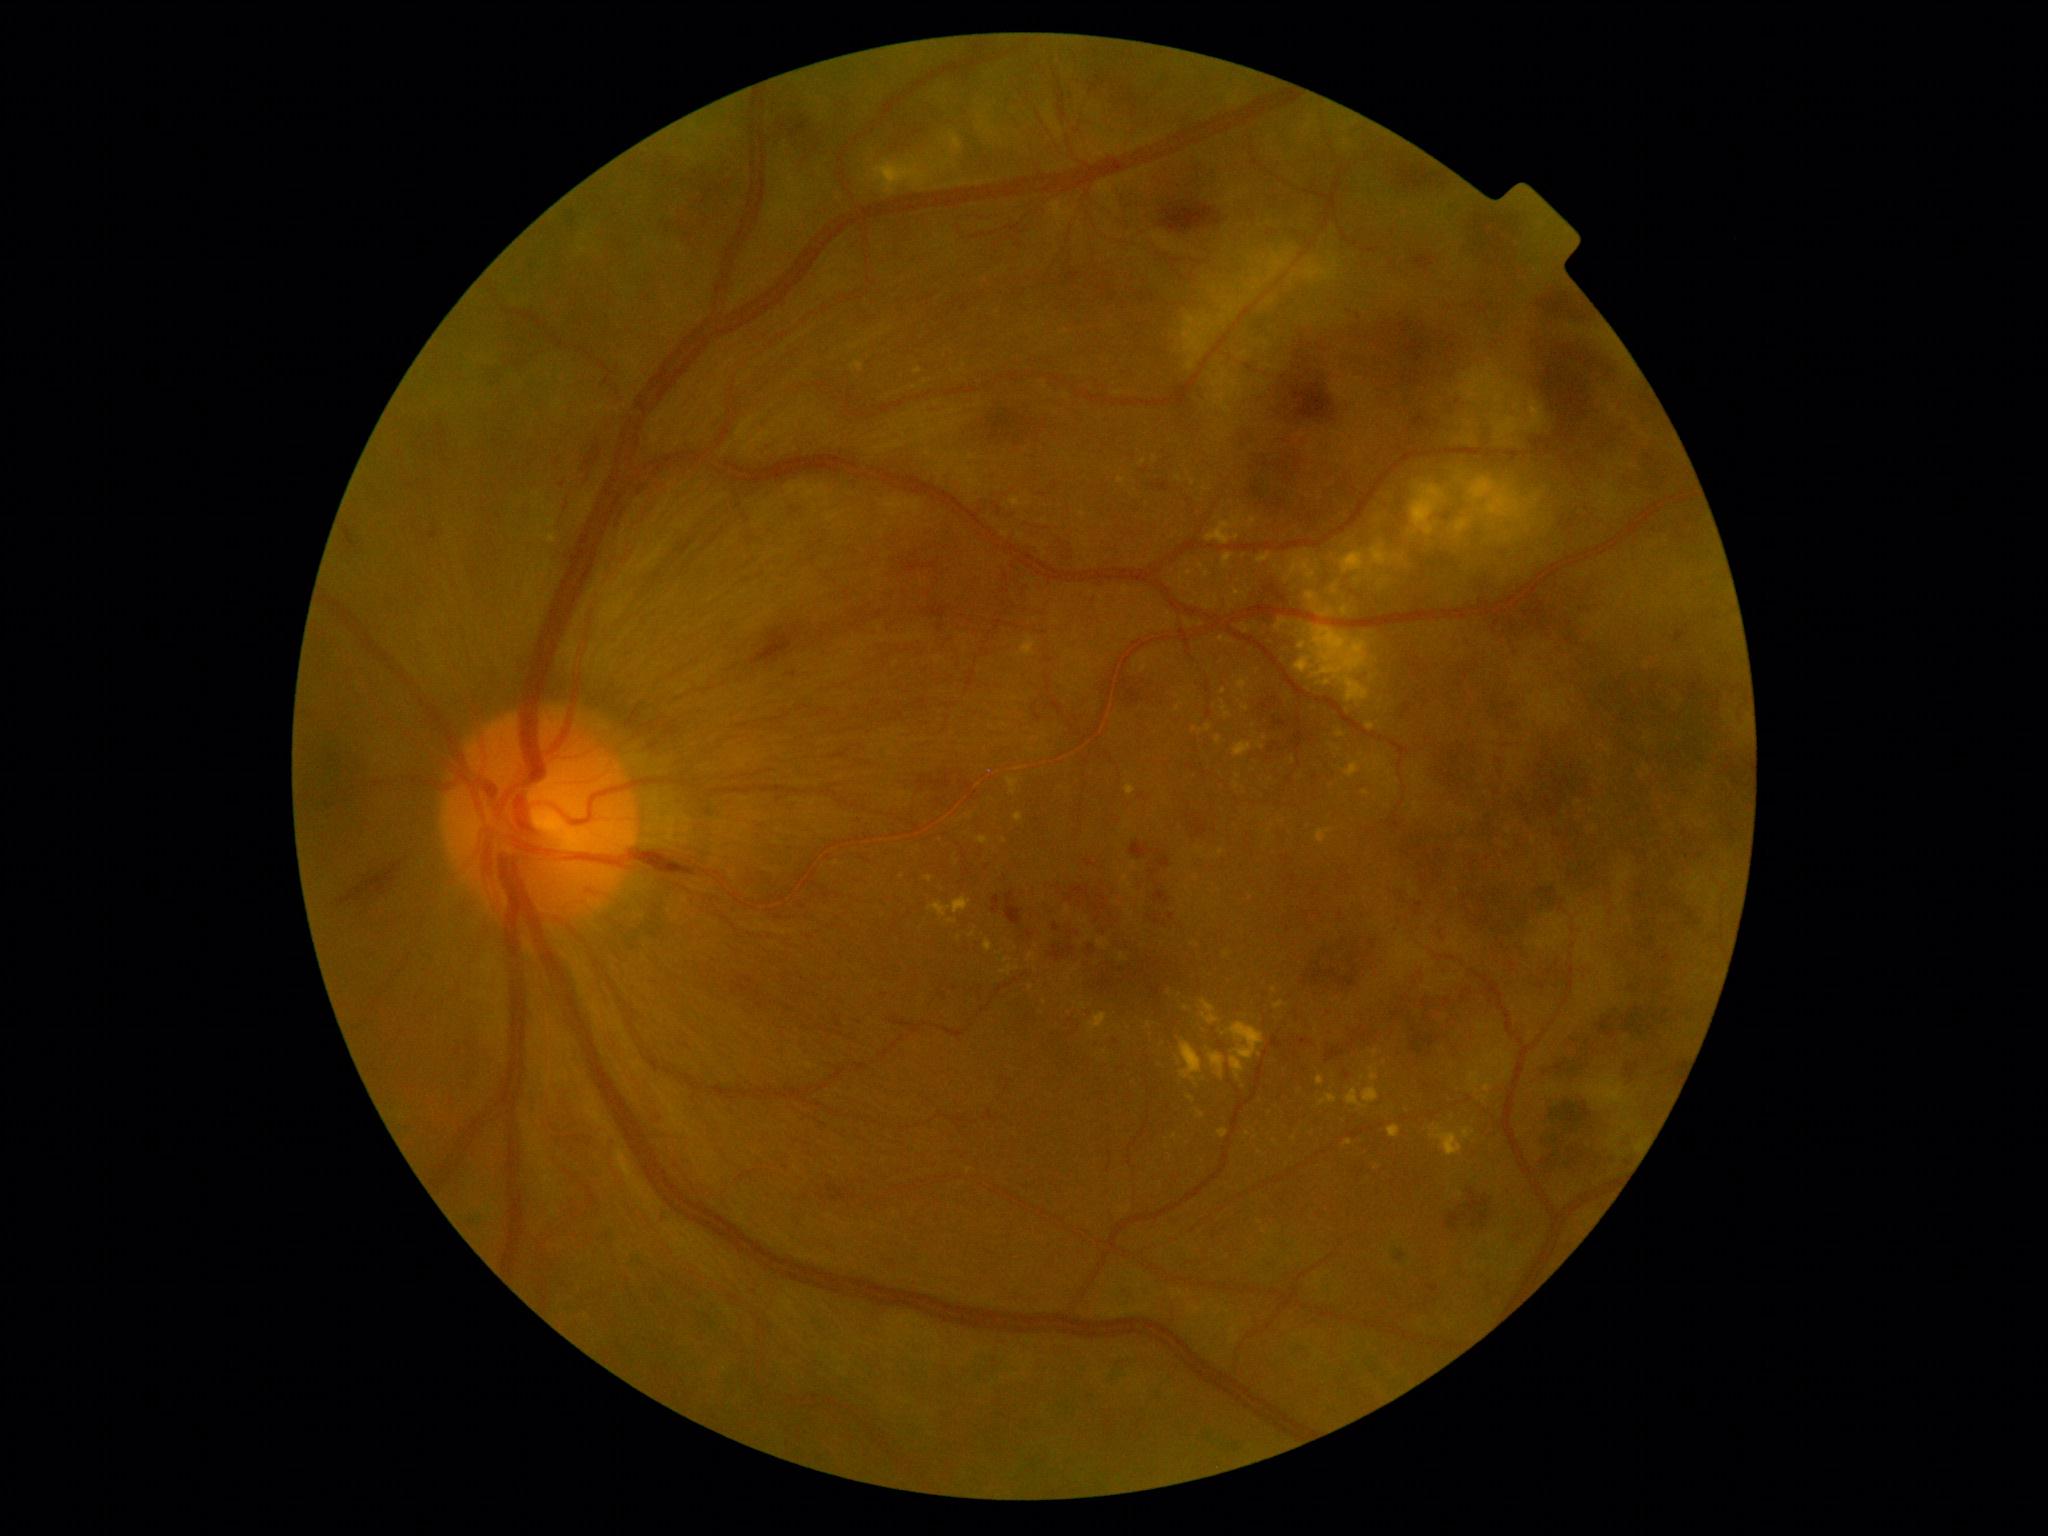

Diabetic retinopathy (DR) is proliferative diabetic retinopathy (grade 4)
Selected lesions:
hard exudates (EXs) (continued) = box=[1098, 939, 1107, 949] | box=[932, 159, 956, 172] | box=[925, 876, 933, 882] | box=[1204, 570, 1211, 579] | box=[1221, 1022, 1264, 1080] | box=[1141, 657, 1148, 673] | box=[1462, 1127, 1476, 1140] | box=[1201, 999, 1221, 1025] | box=[1369, 1067, 1379, 1081]
Small EXs near <pt>1227,954</pt> | <pt>1180,480</pt> | <pt>1082,514</pt> | <pt>1385,1063</pt> | <pt>1294,1139</pt> | <pt>1005,841</pt> | <pt>926,382</pt> | <pt>957,861</pt> | <pt>1179,1062</pt>